ONH-centered crop from a color fundus image.
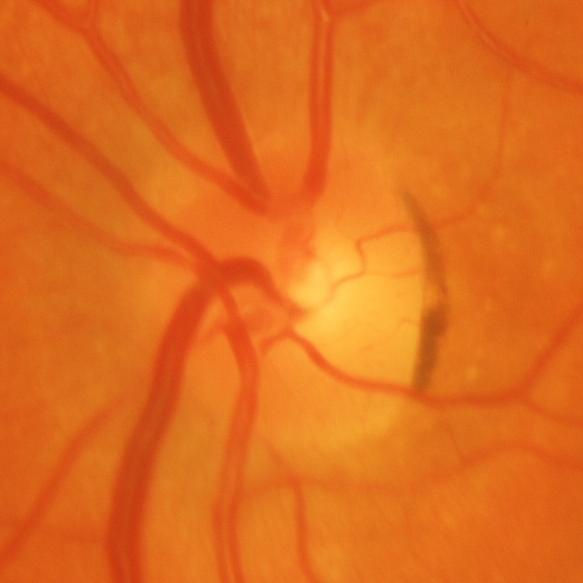 Glaucomatous optic neuropathy is present. The image shows glaucomatous findings.